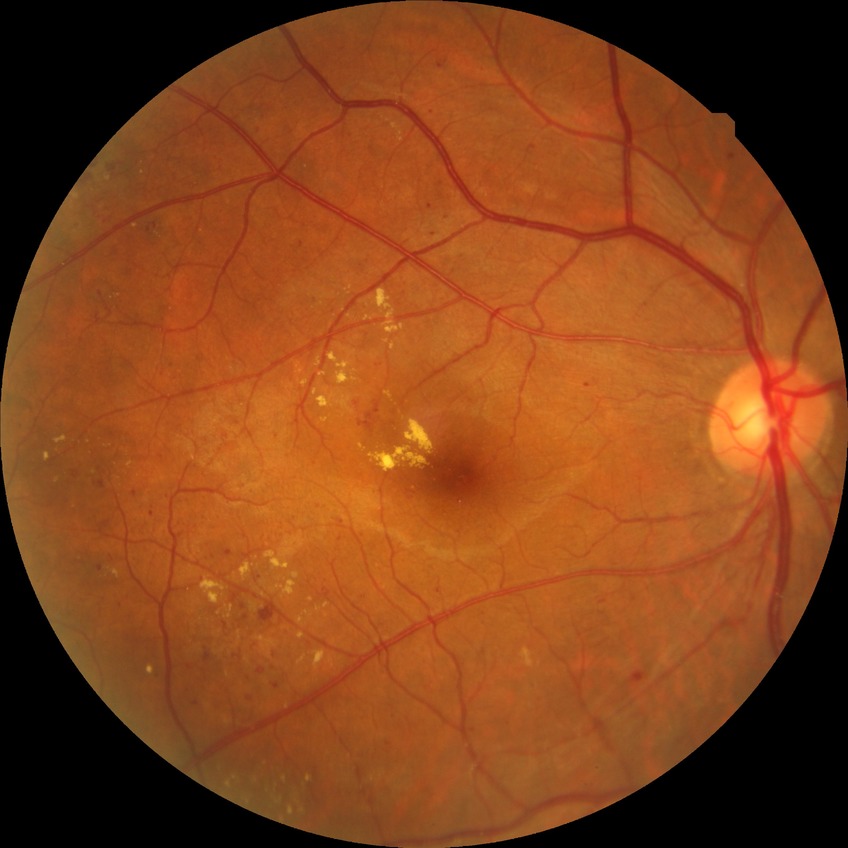

Retinopathy stage: proliferative diabetic retinopathy.